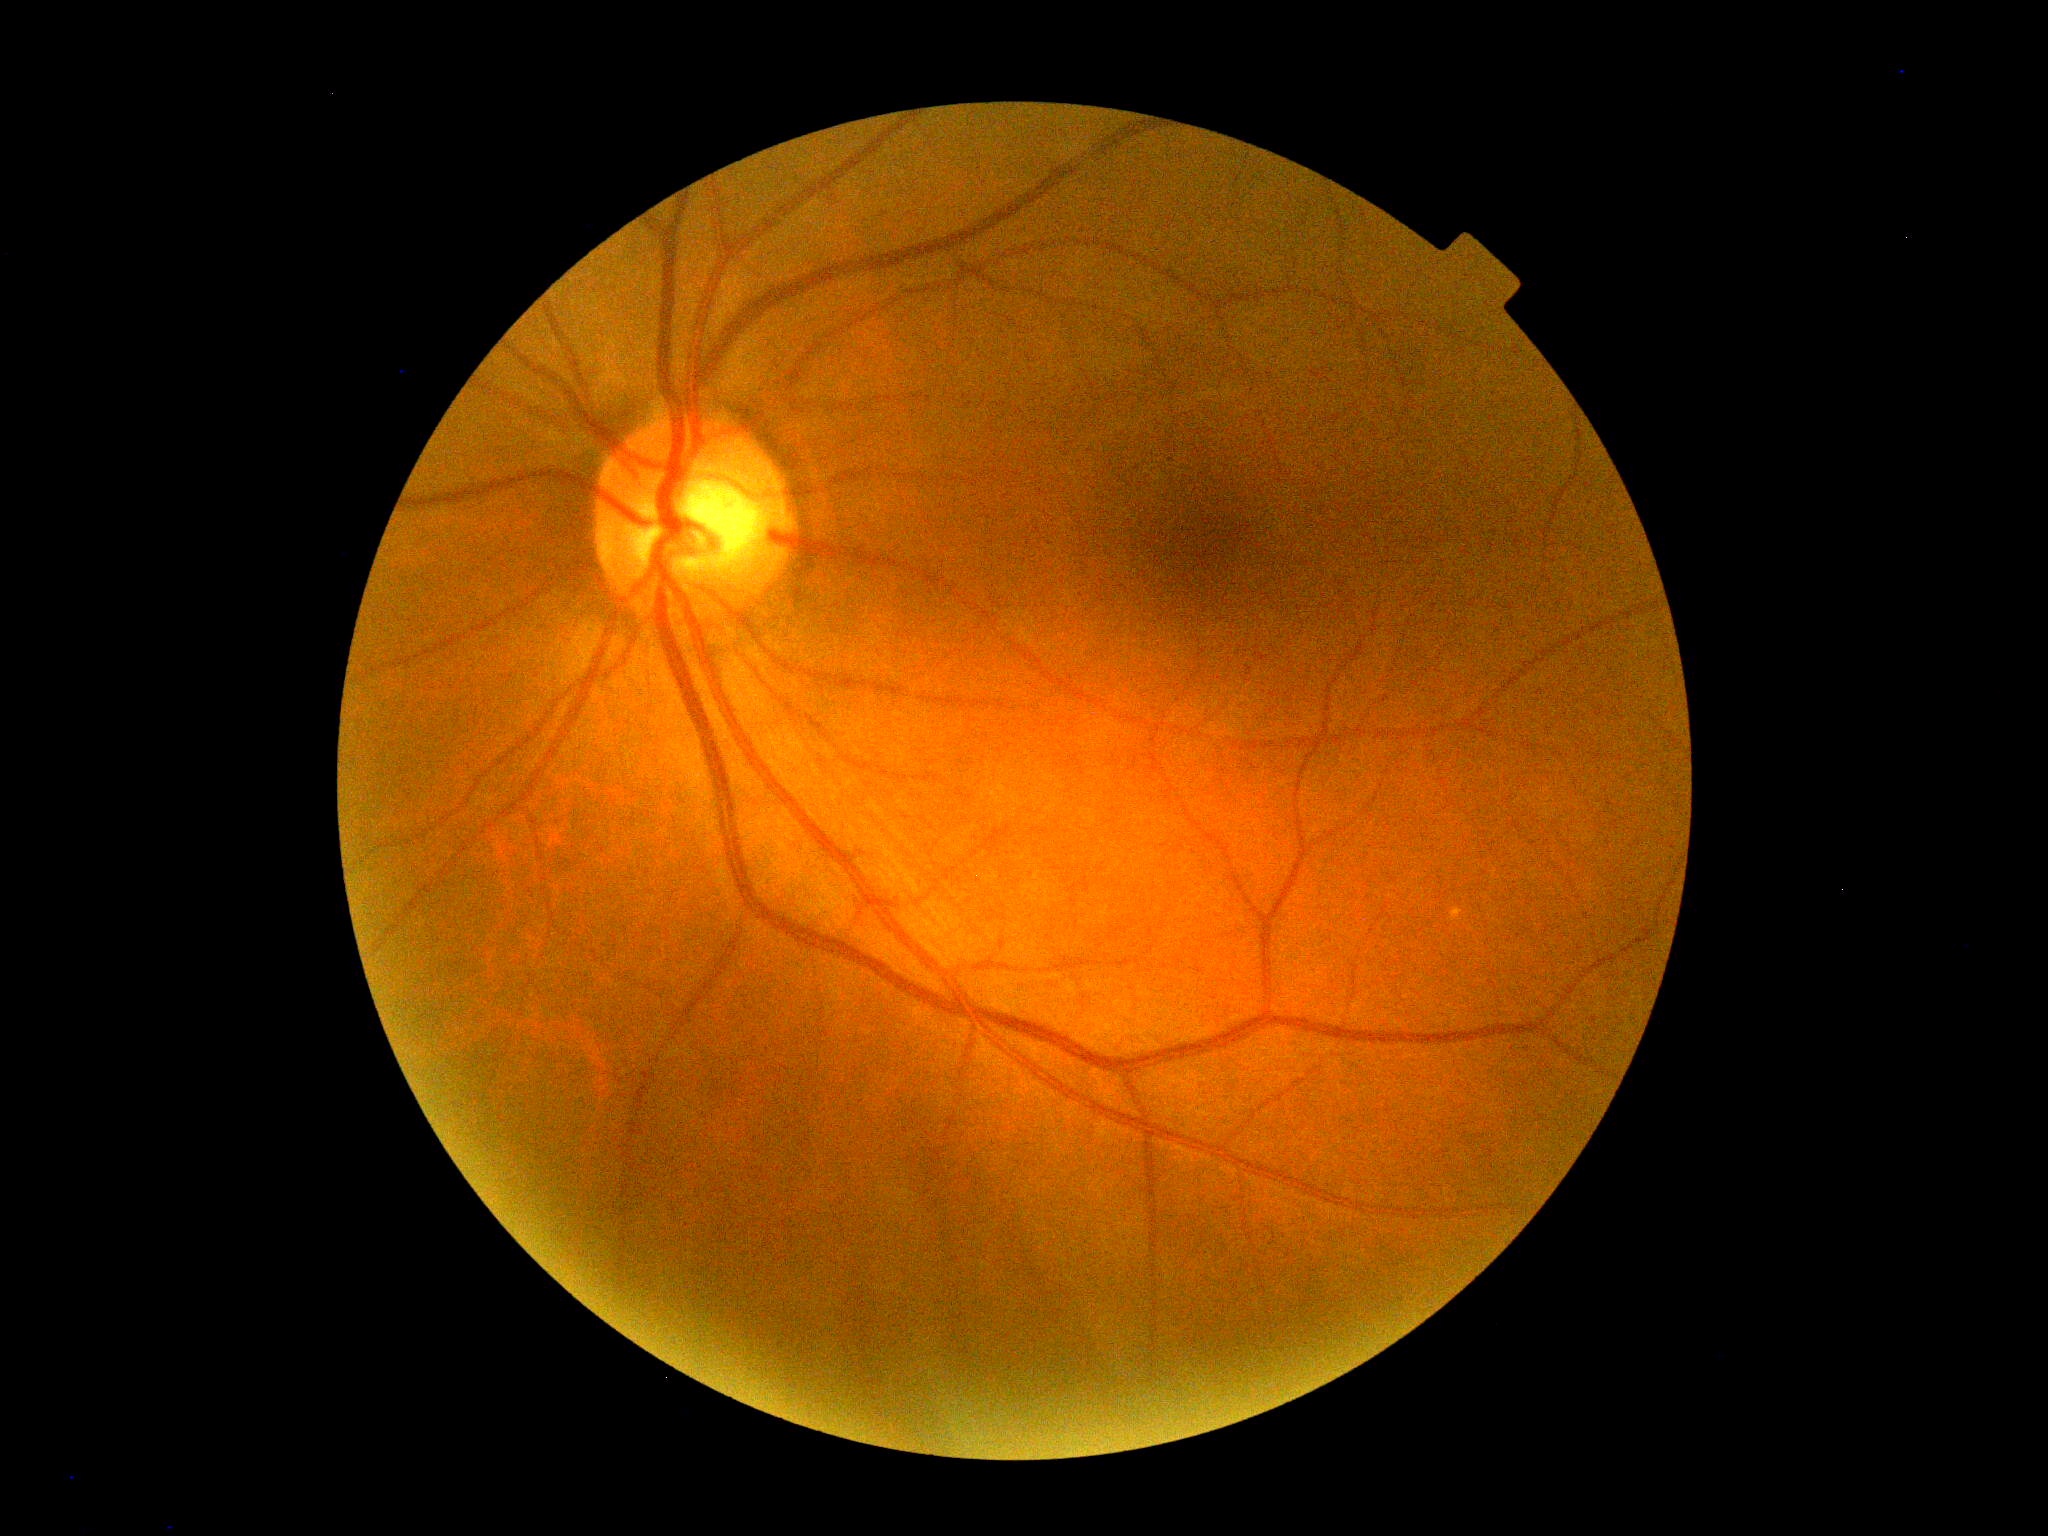 DR impression=negative for DR; diabetic retinopathy (DR)=no apparent retinopathy (grade 0).